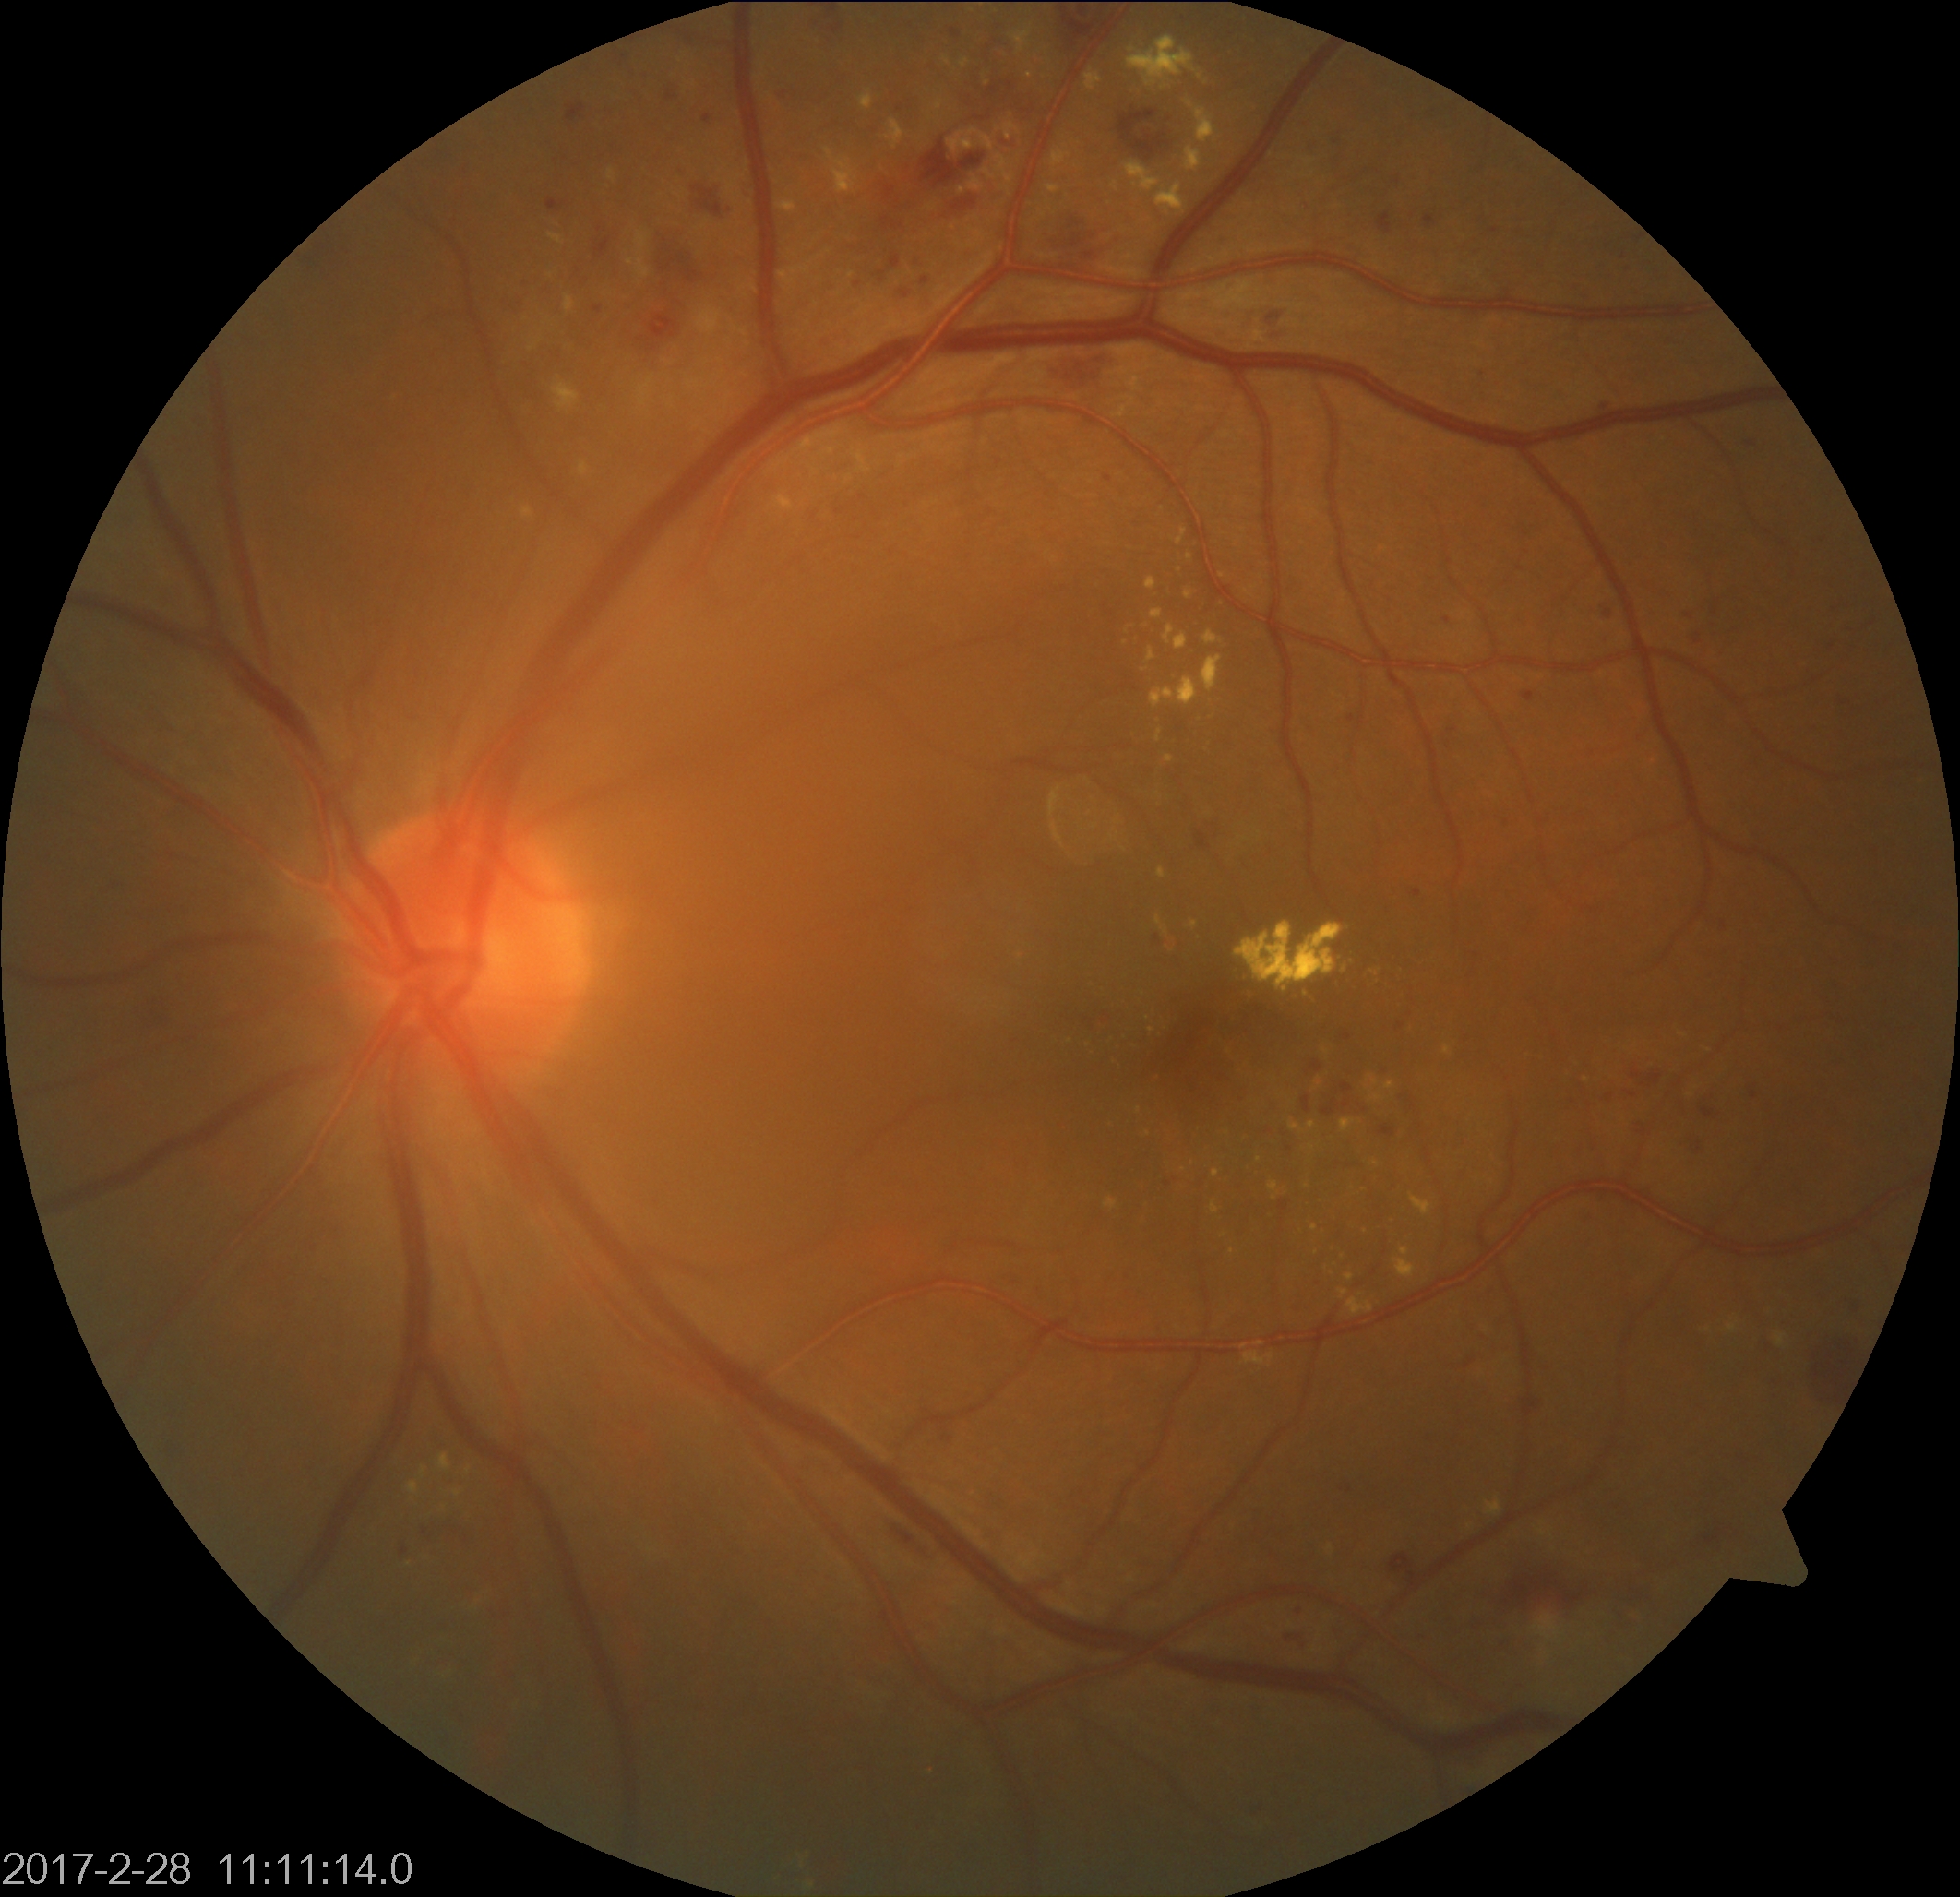
Findings: moderate non-proliferative diabetic retinopathy.